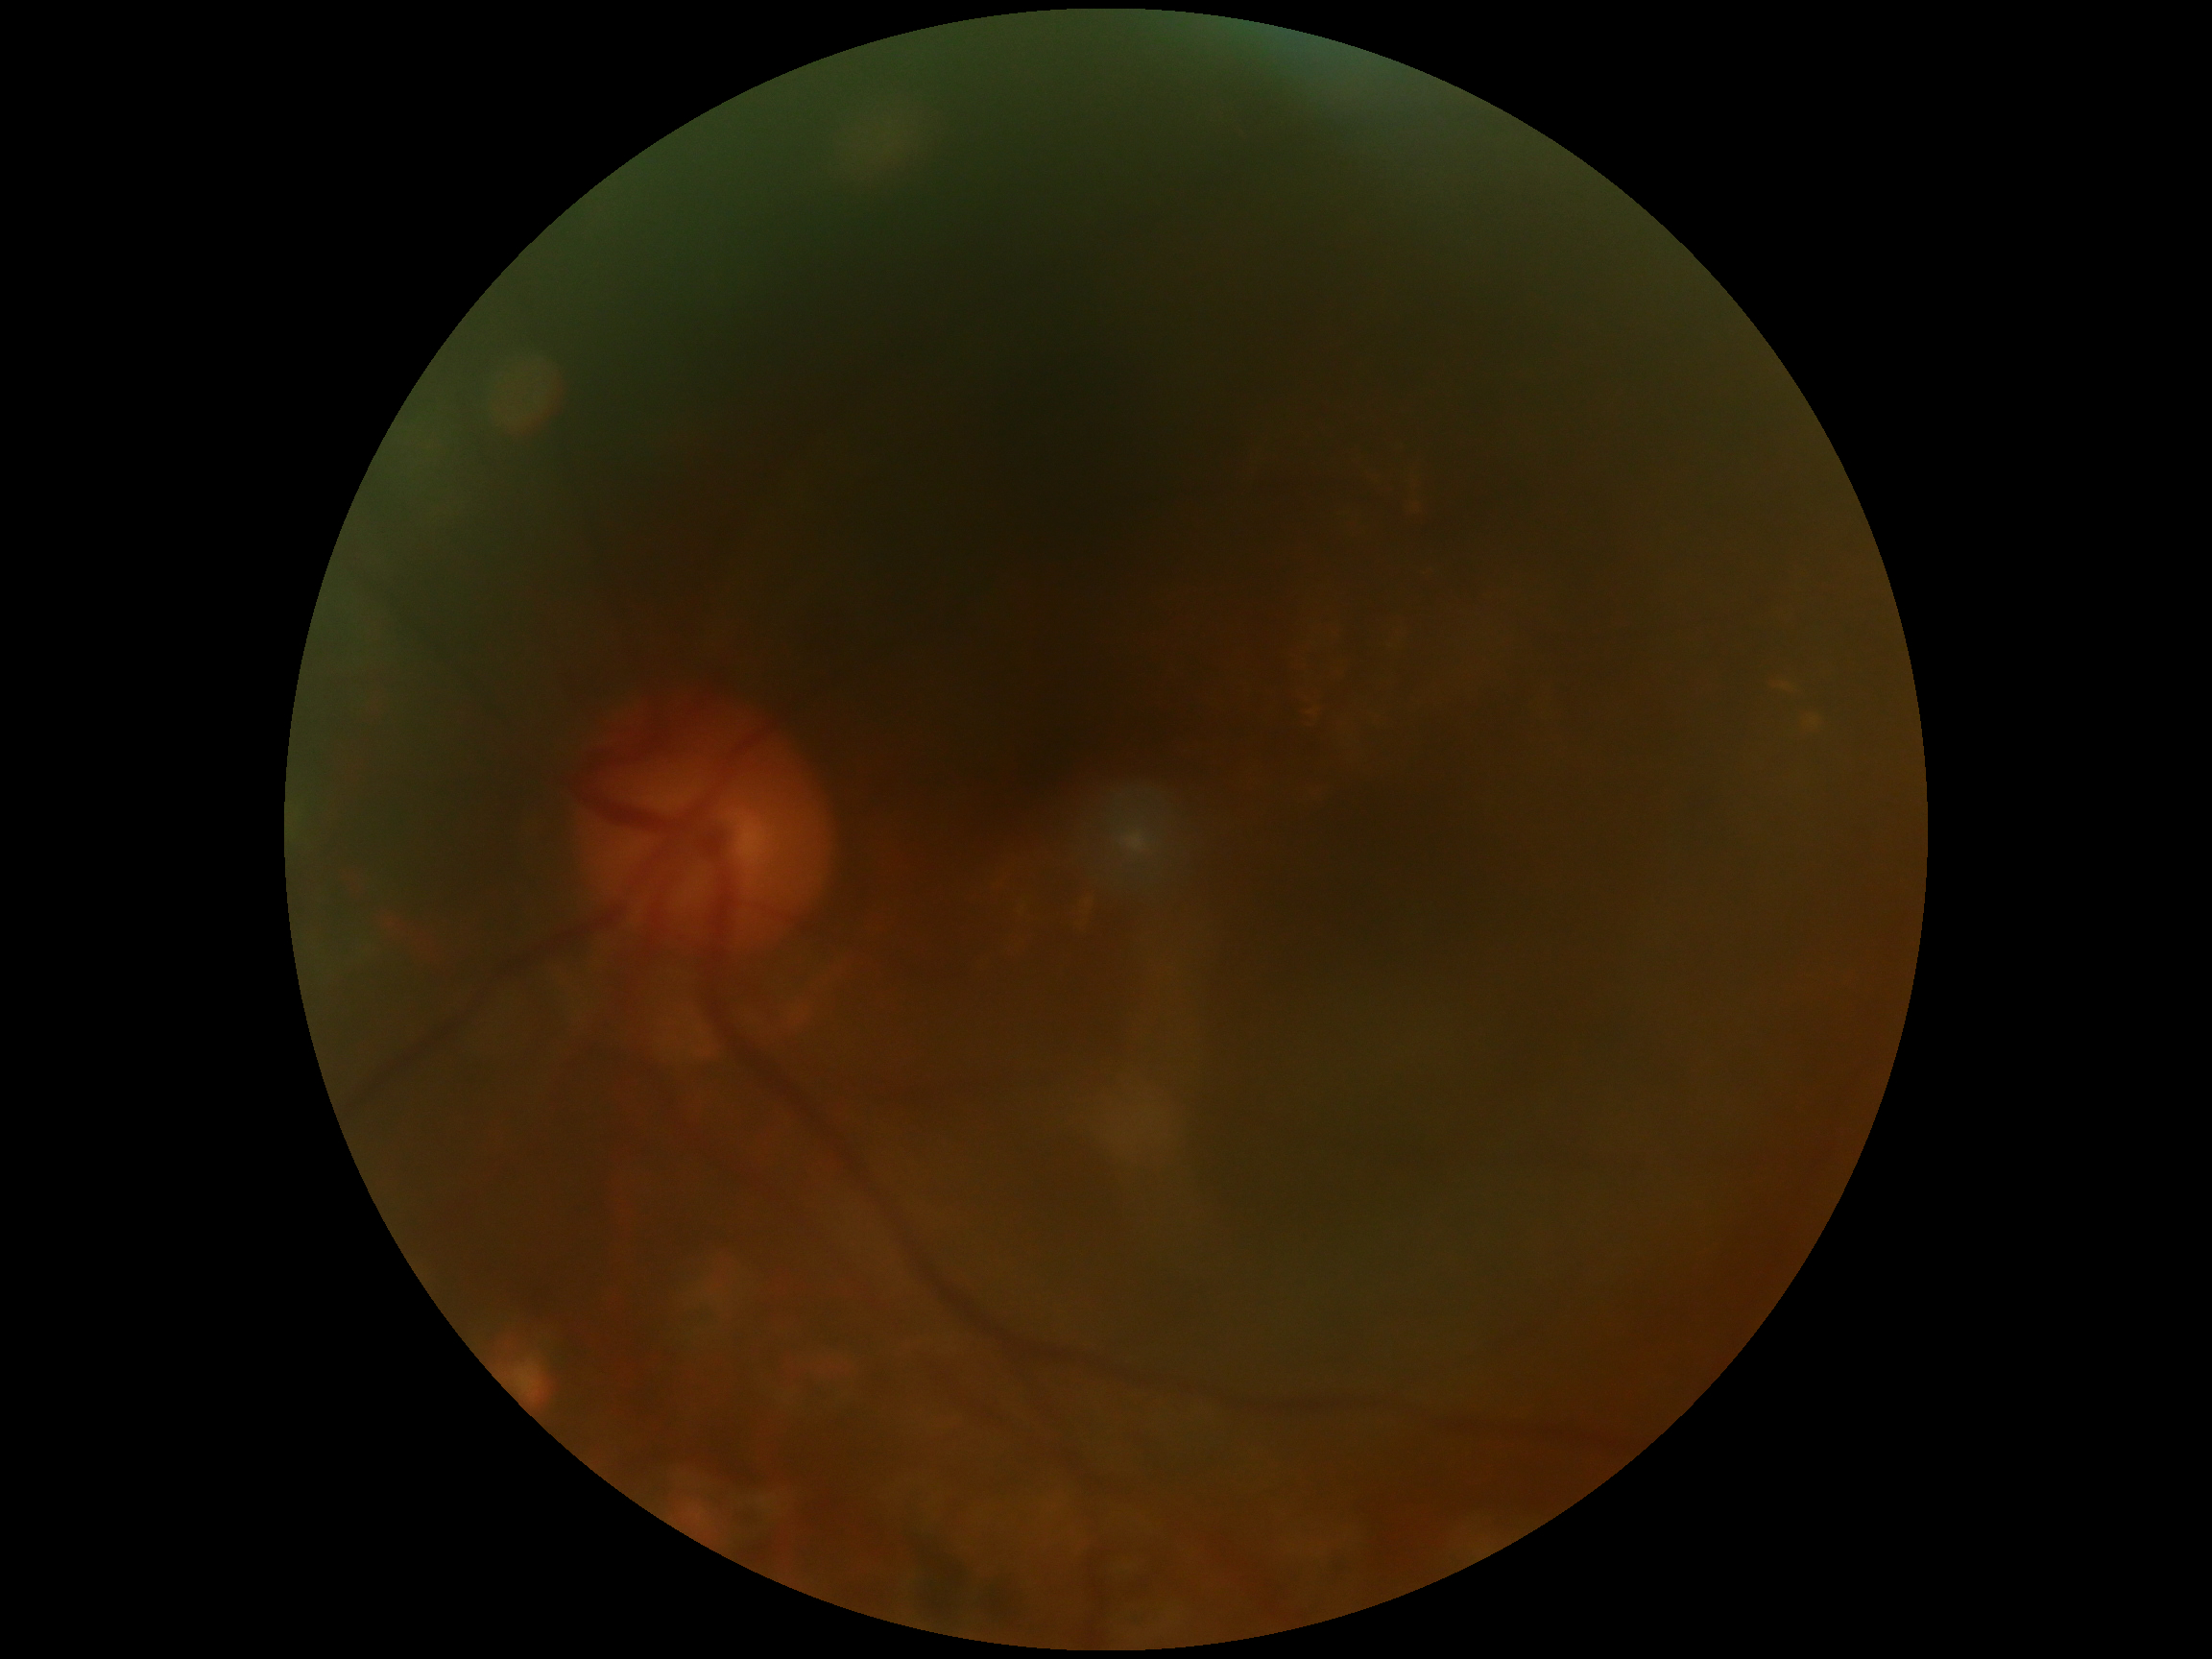 Findings:
– DR grade: ungradable
– image quality: insufficient